1932x1932px:
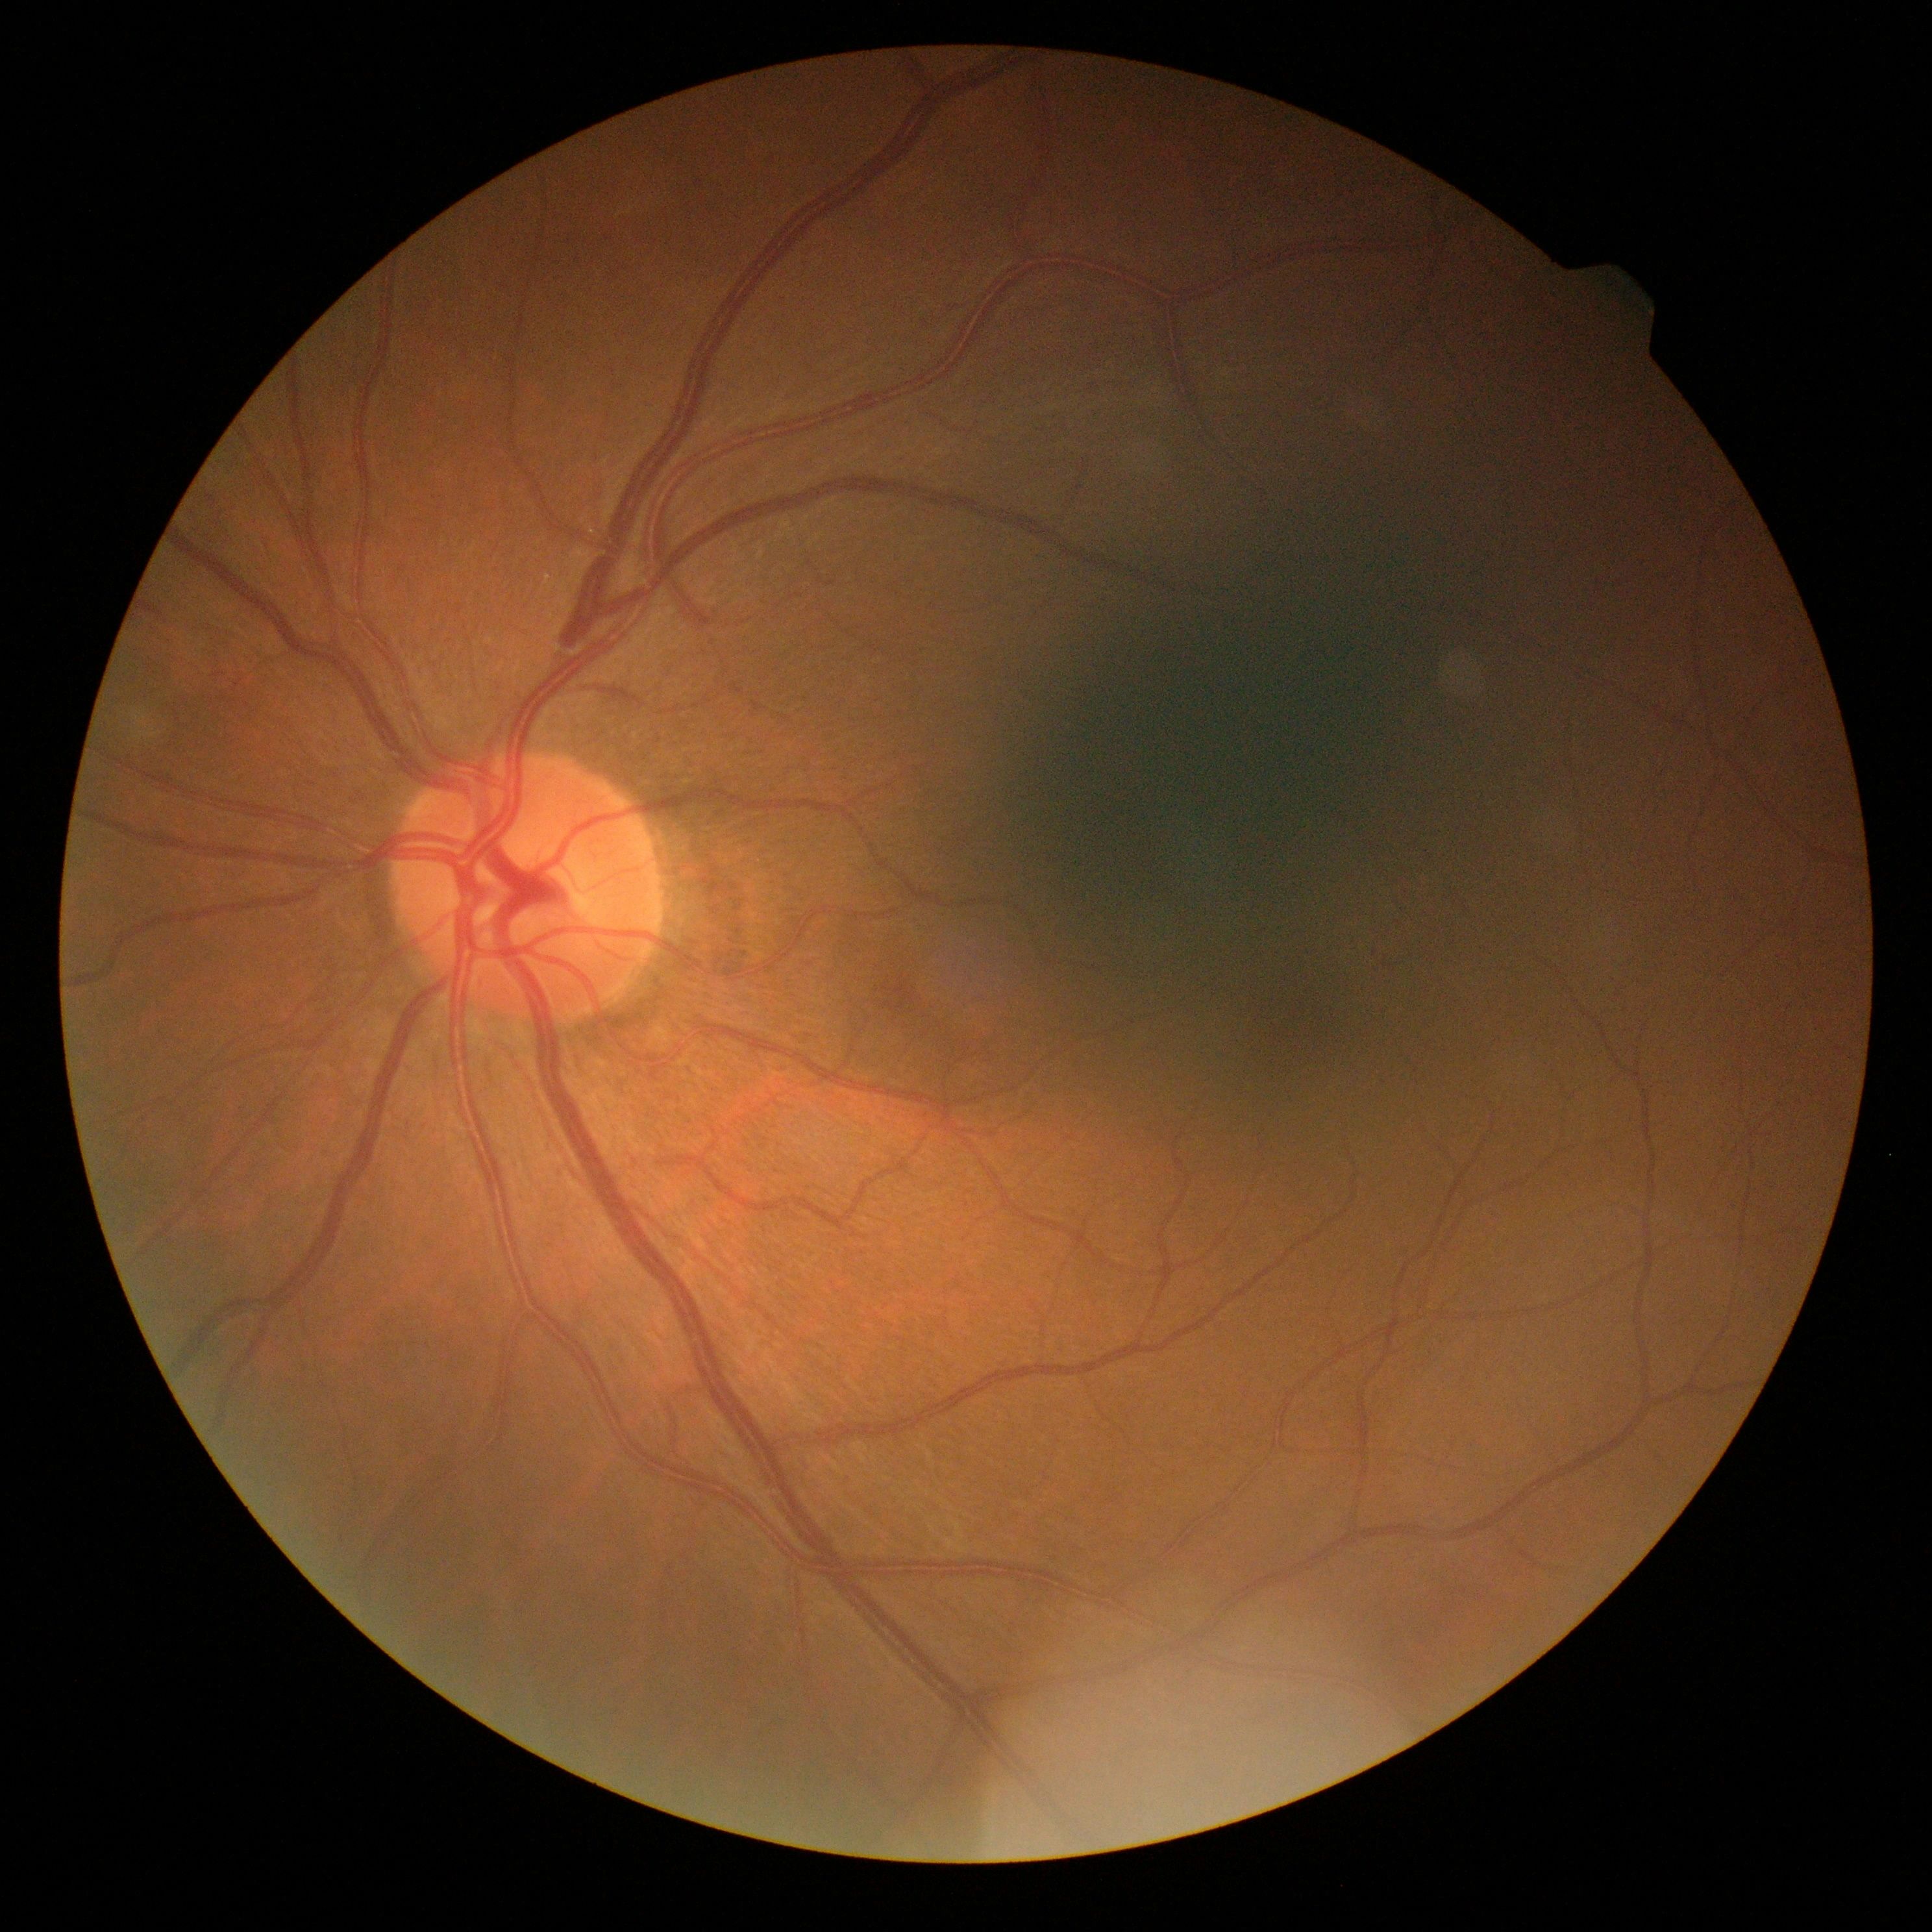 * retinopathy — no apparent diabetic retinopathy (grade 0)